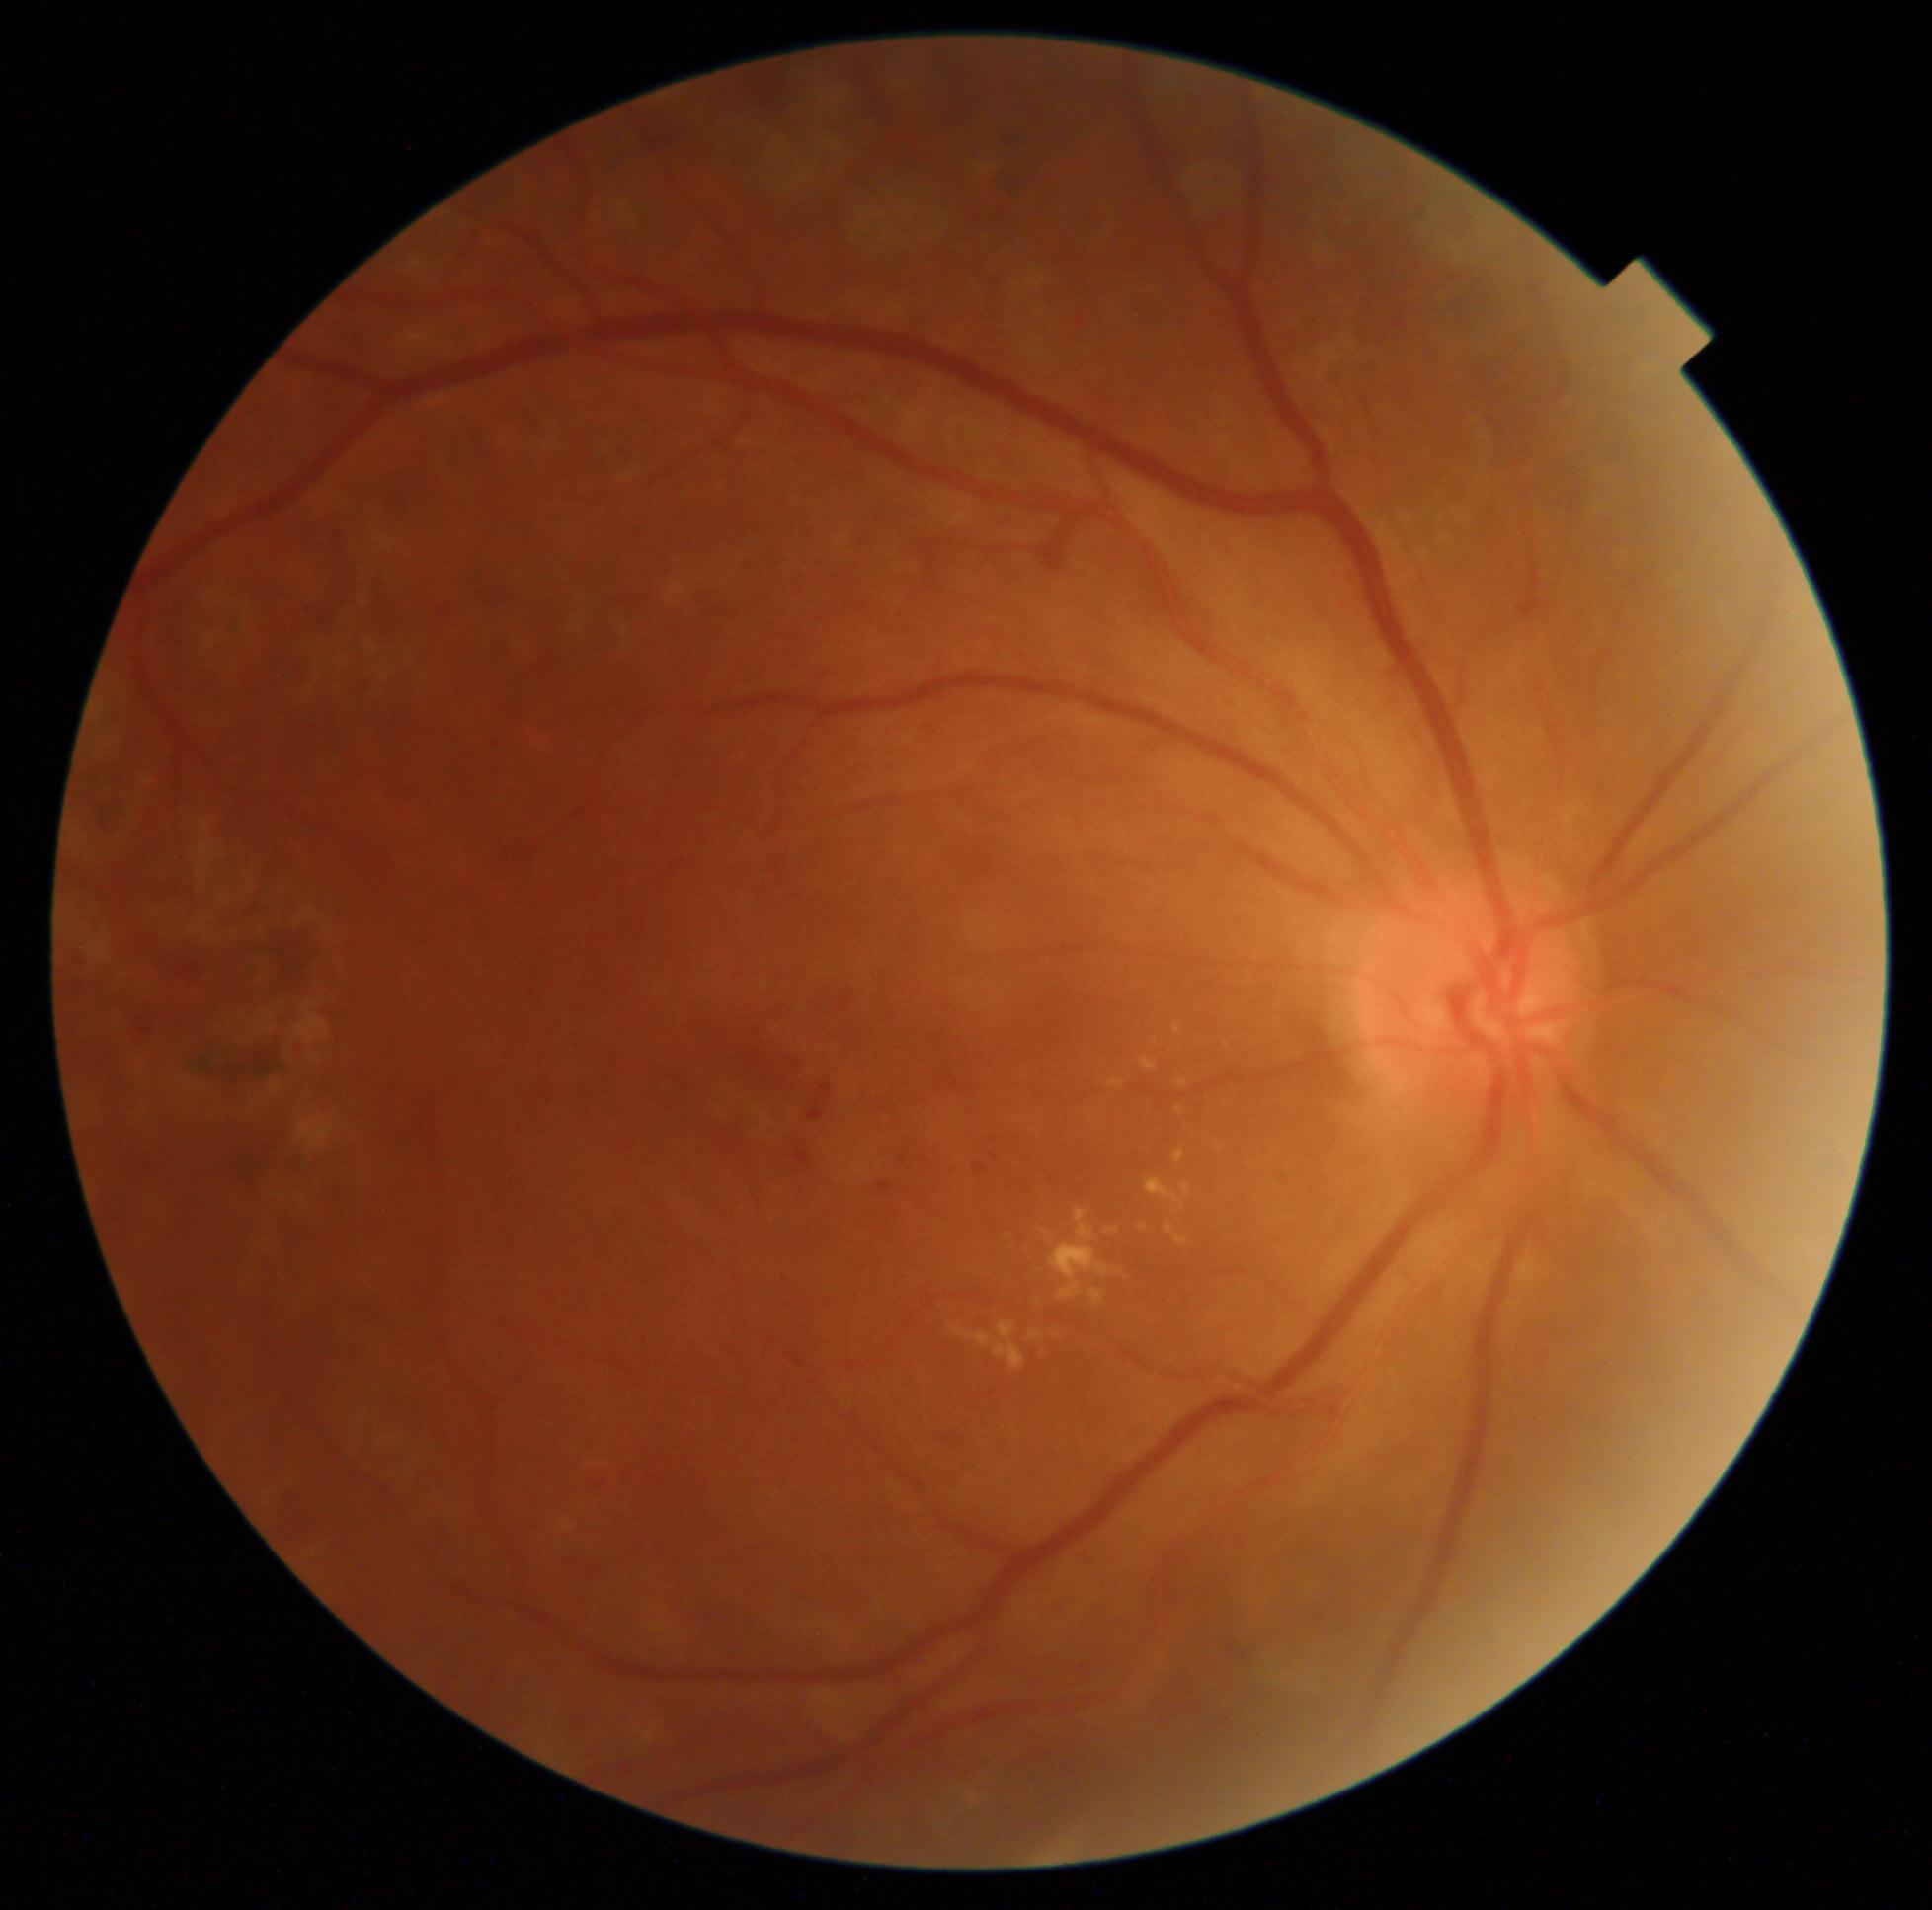
{"dr_grade": "moderate non-proliferative diabetic retinopathy (2)"}